45 degree fundus photograph. 848x848: 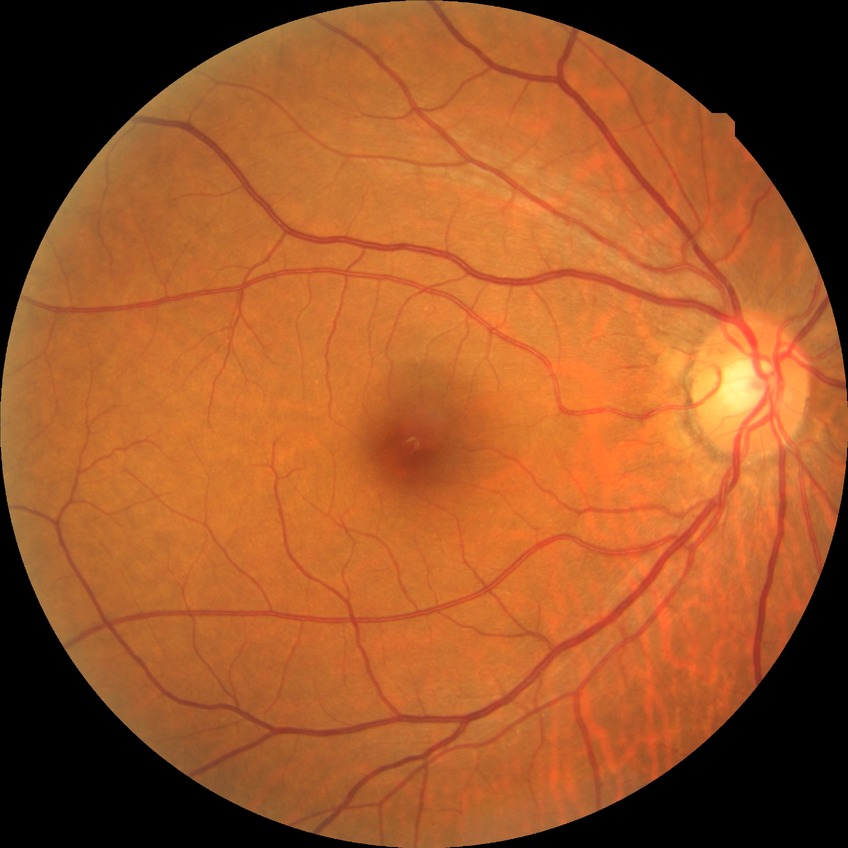
Diabetic retinopathy (DR): NDR (no diabetic retinopathy).